Modified Davis grading · 848x848.
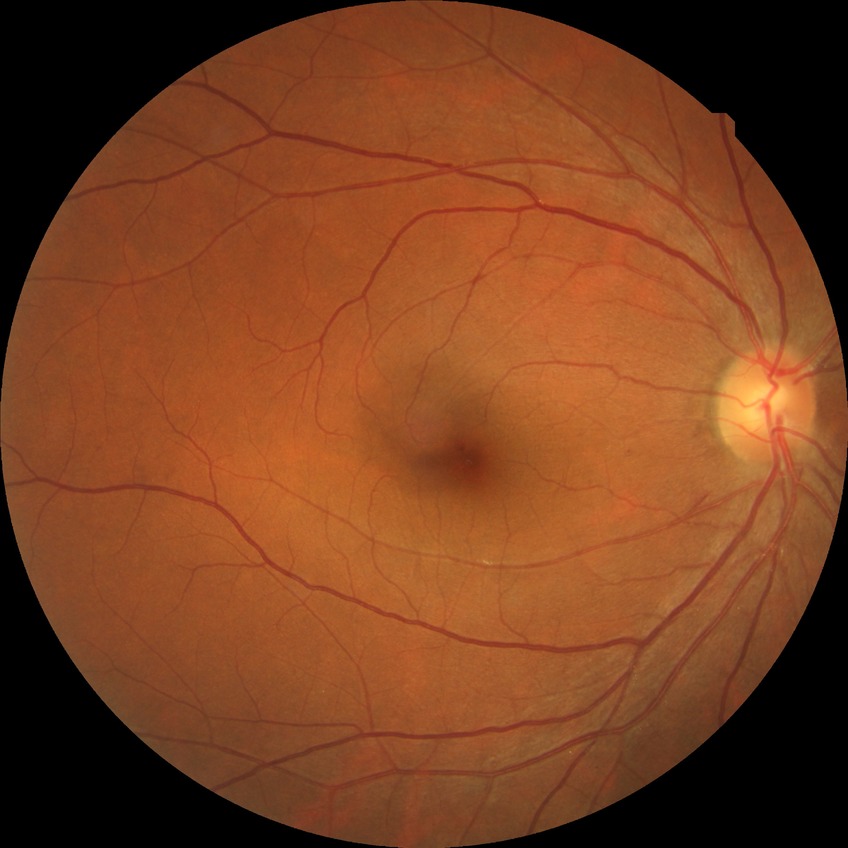

Davis stage = SDR.